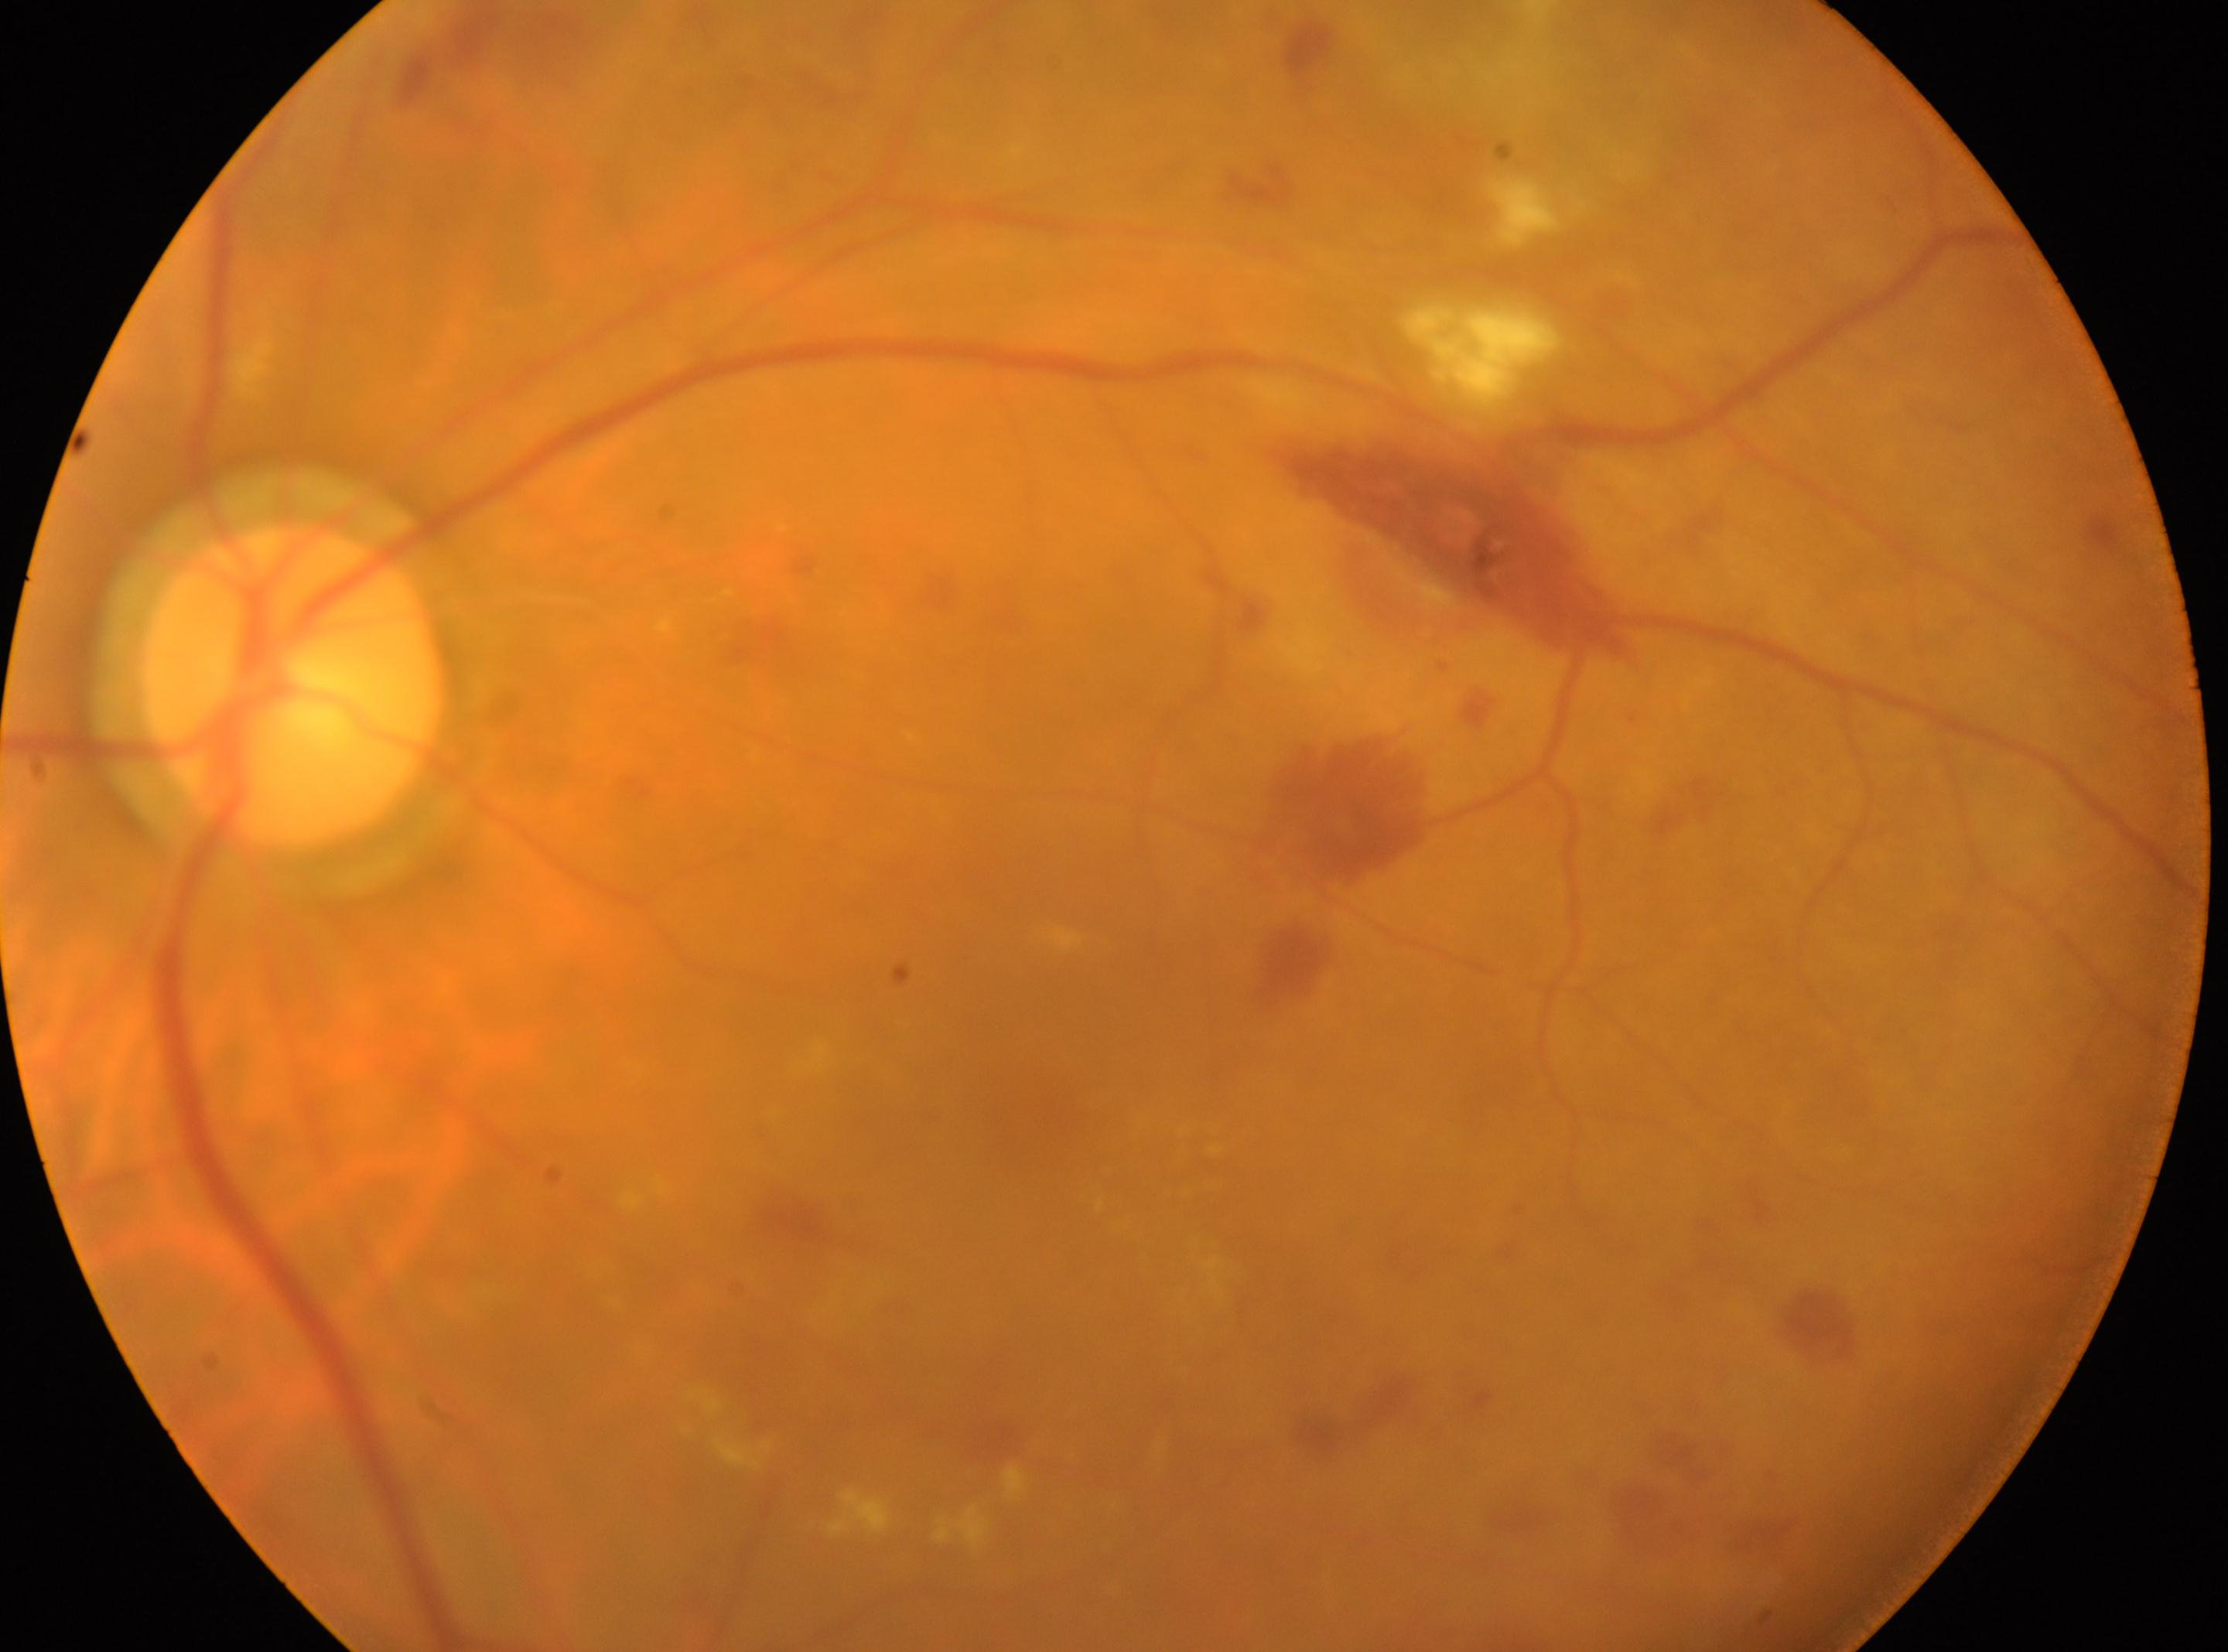 Optic disk located at x=294, y=685. The retinopathy is classified as non-proliferative diabetic retinopathy. DR severity: 2. Imaged eye: left eye. The macula center is at x=1049, y=1101.